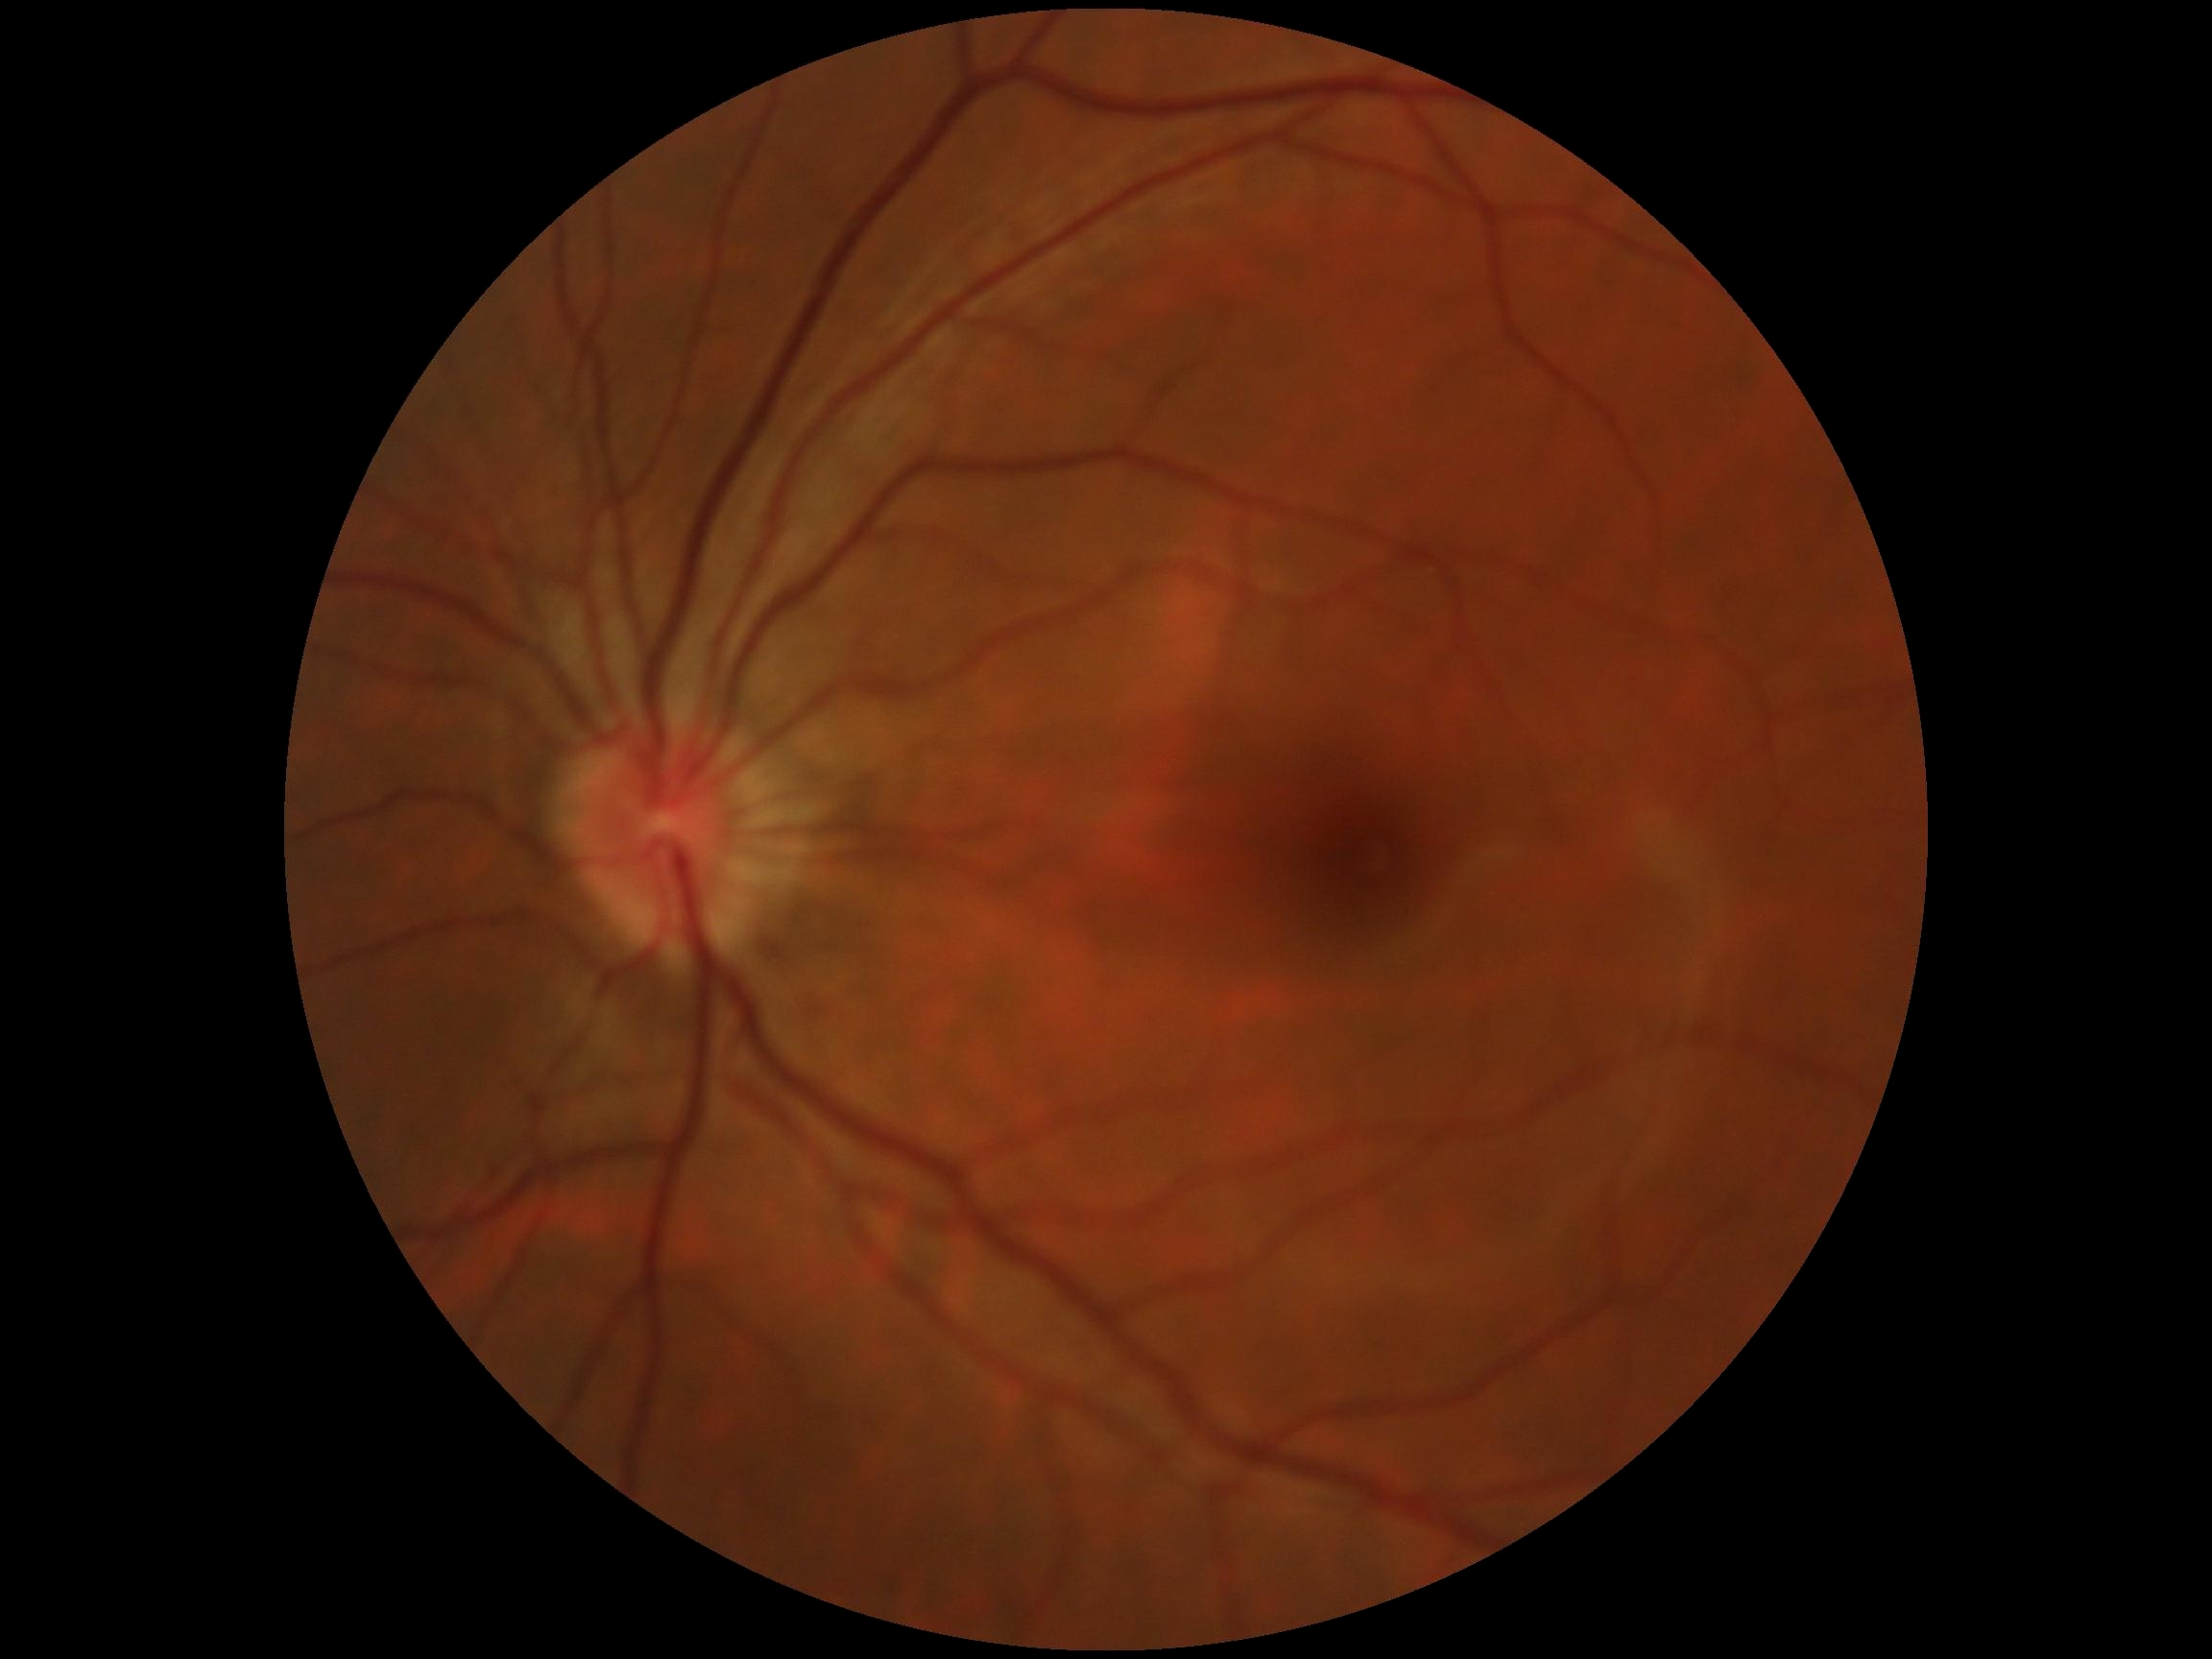

DR impression: negative for DR | DR stage: grade 0 (no apparent retinopathy).